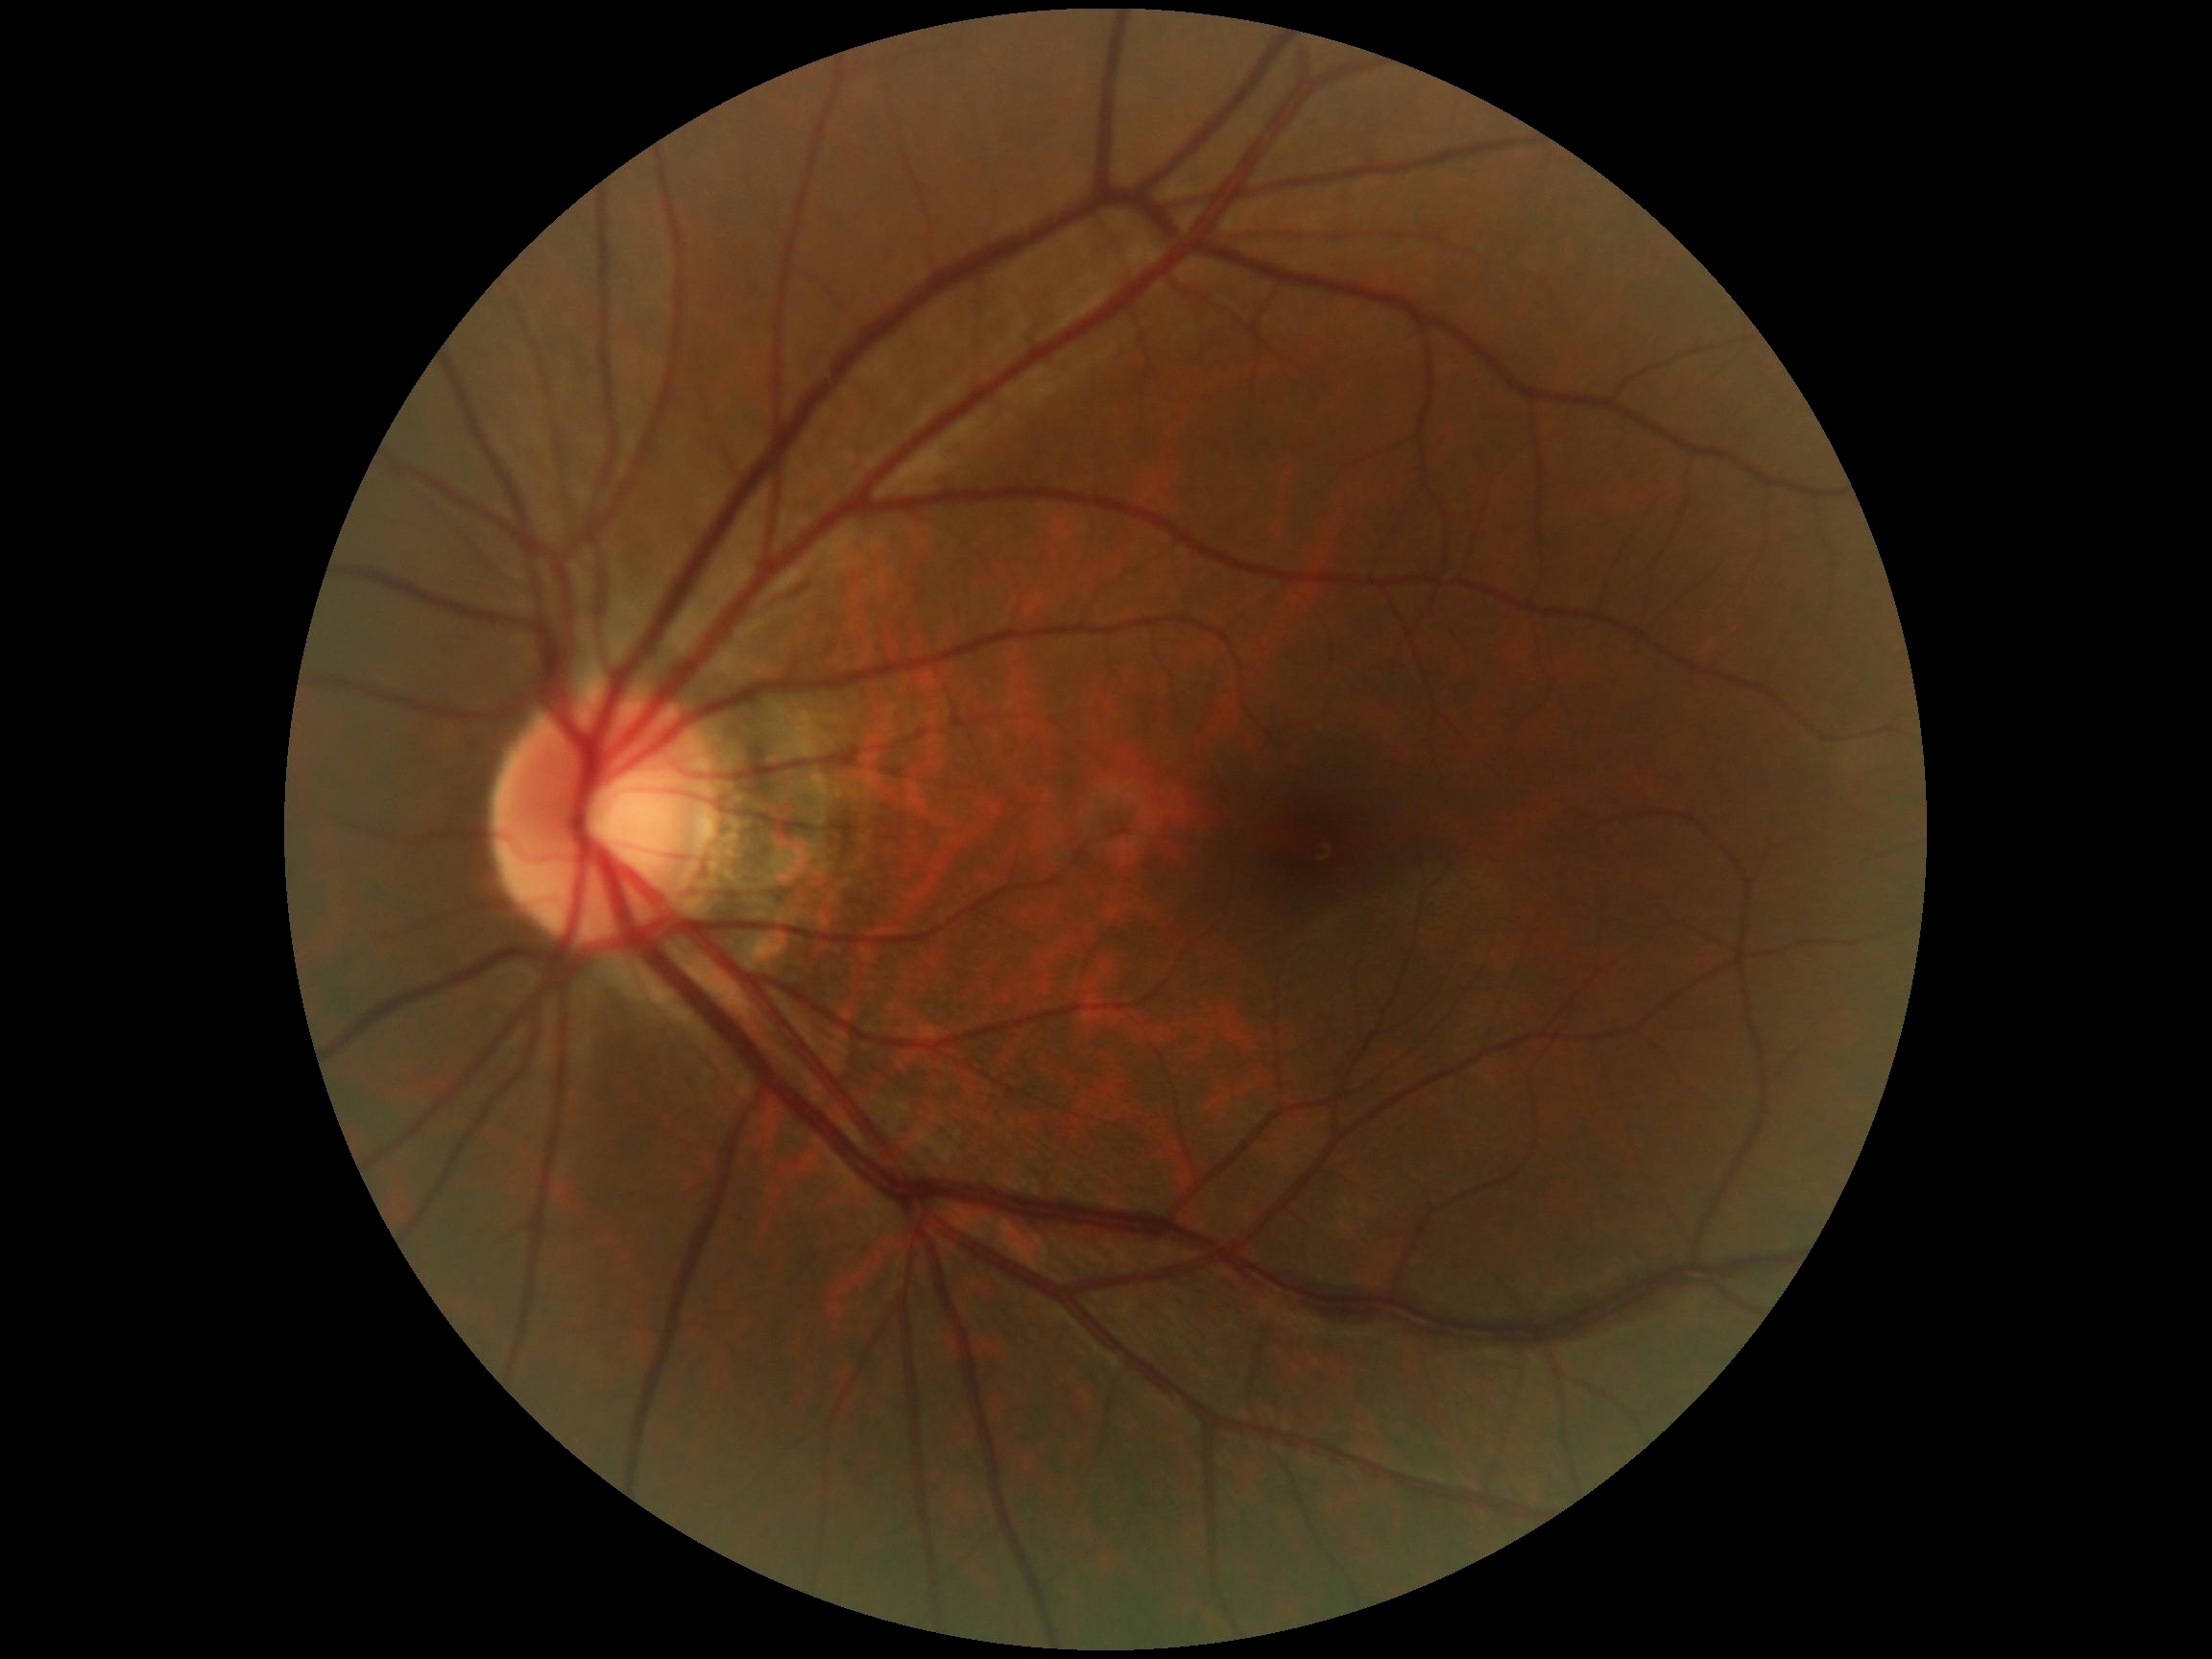

Diabetic retinopathy grade: 0/4.